Infant wide-field retinal image · 640 by 480 pixels
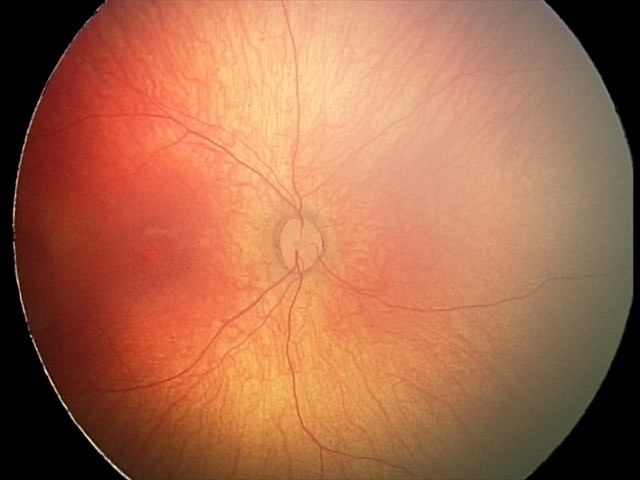
Q: What is the diagnosis from this examination?
A: physiological appearance with no retinal pathology